Fundus photo, 45° field of view — 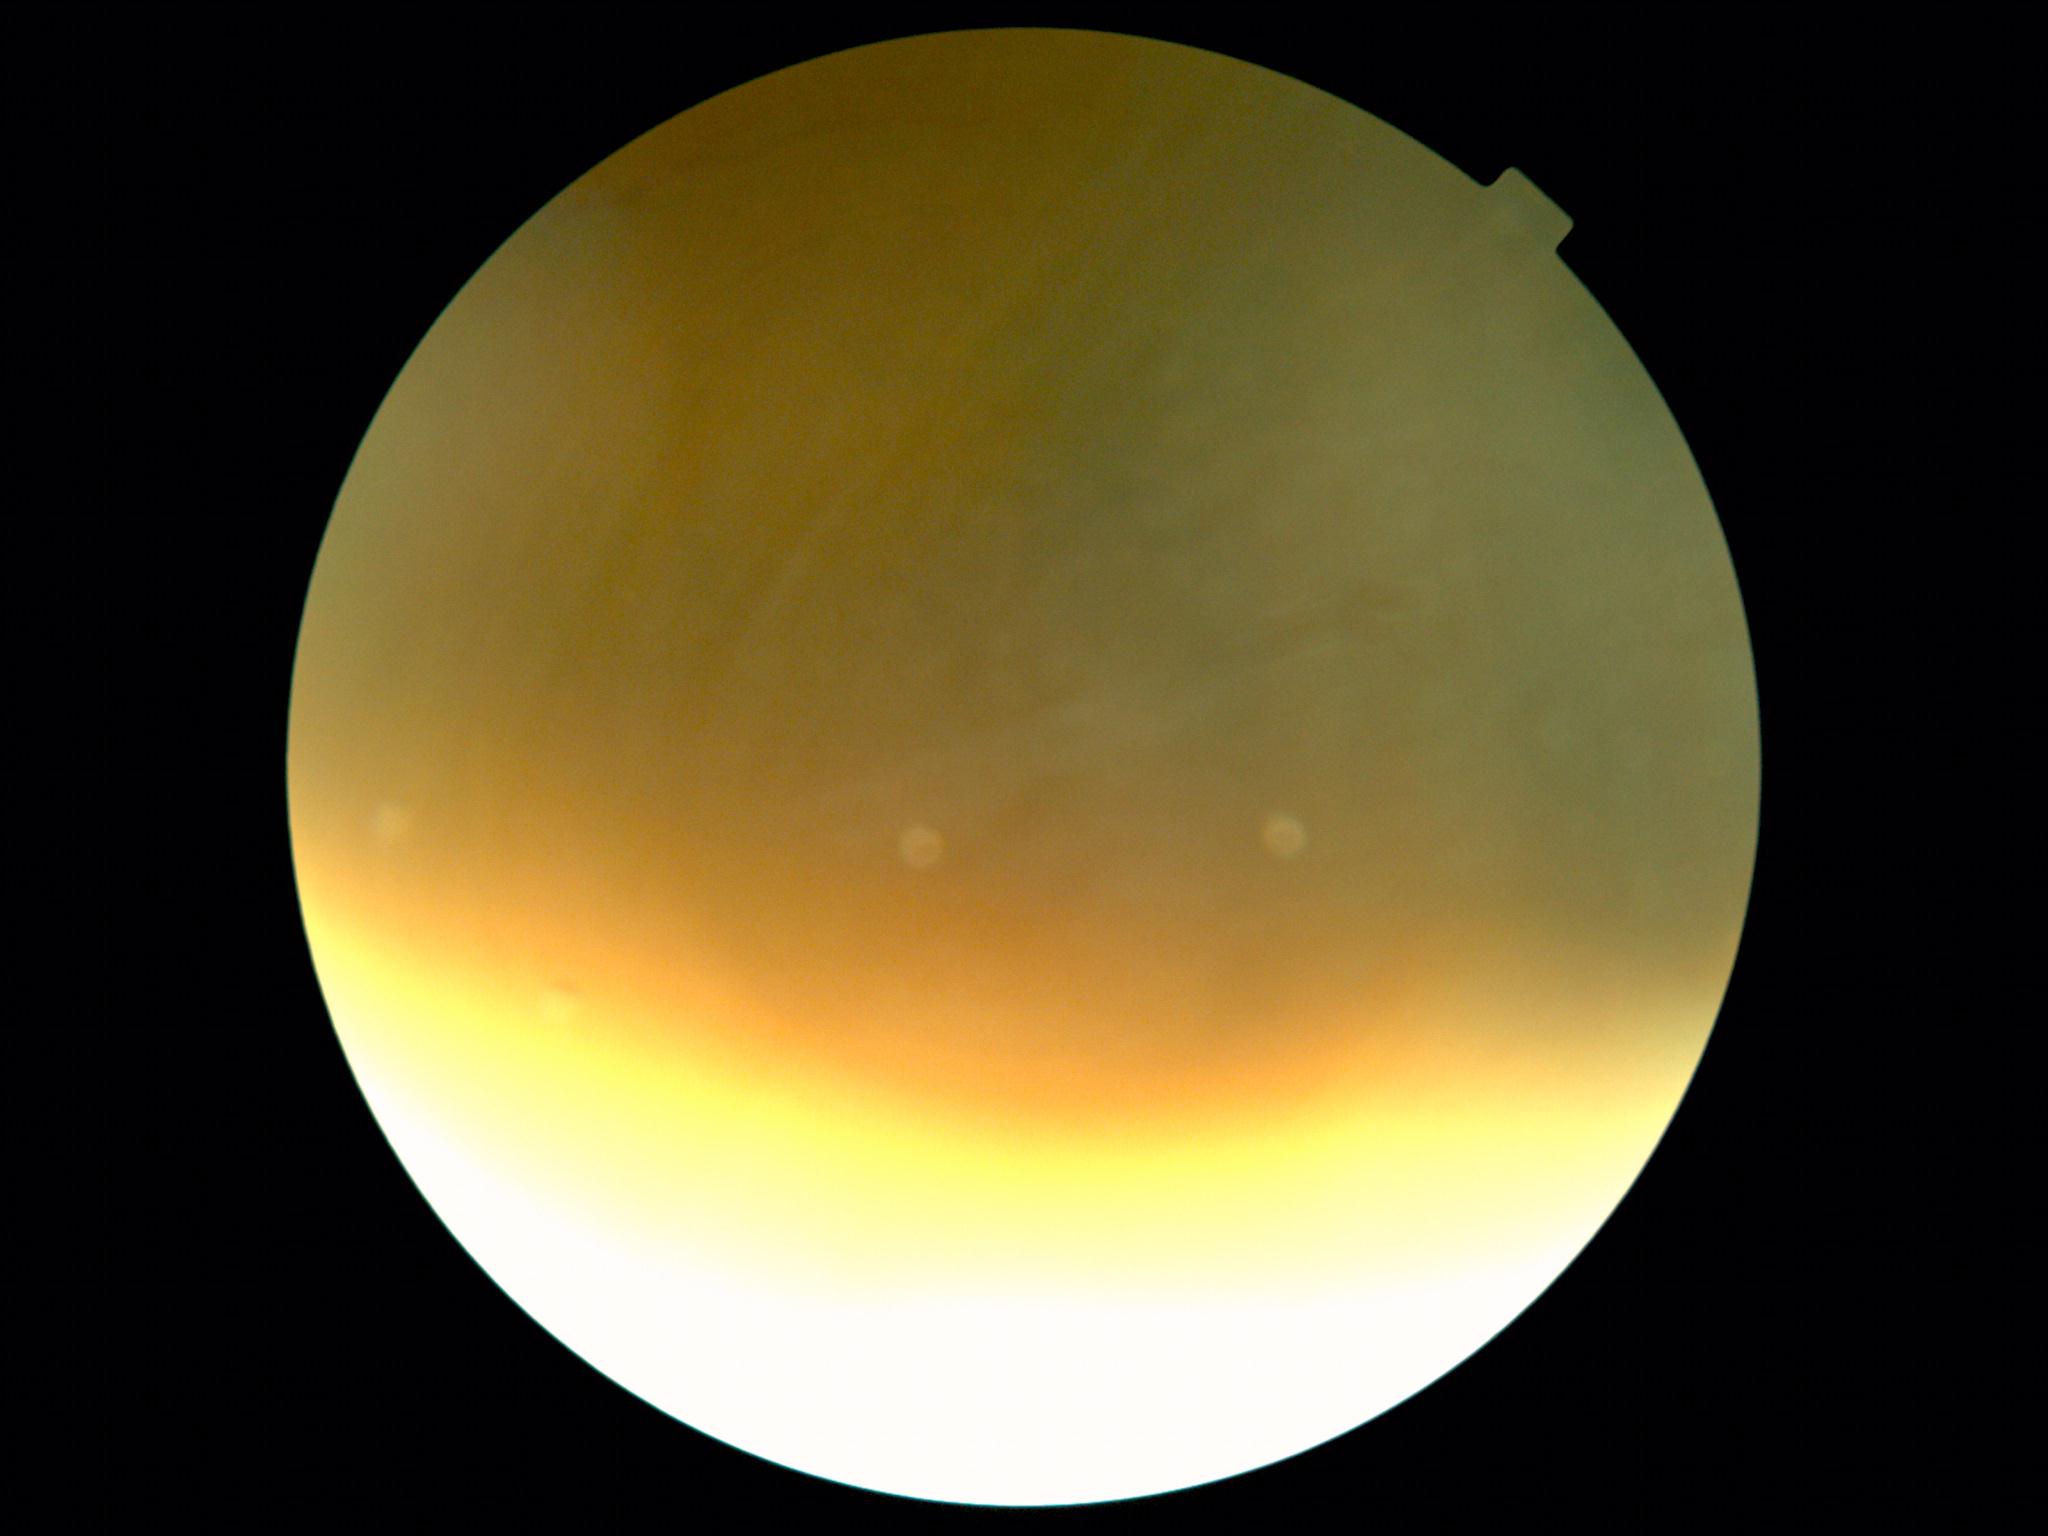

Diabetic retinopathy (DR): ungradable.
Quality too poor to assess for DR.